Acquired with a NIDEK AFC-230.
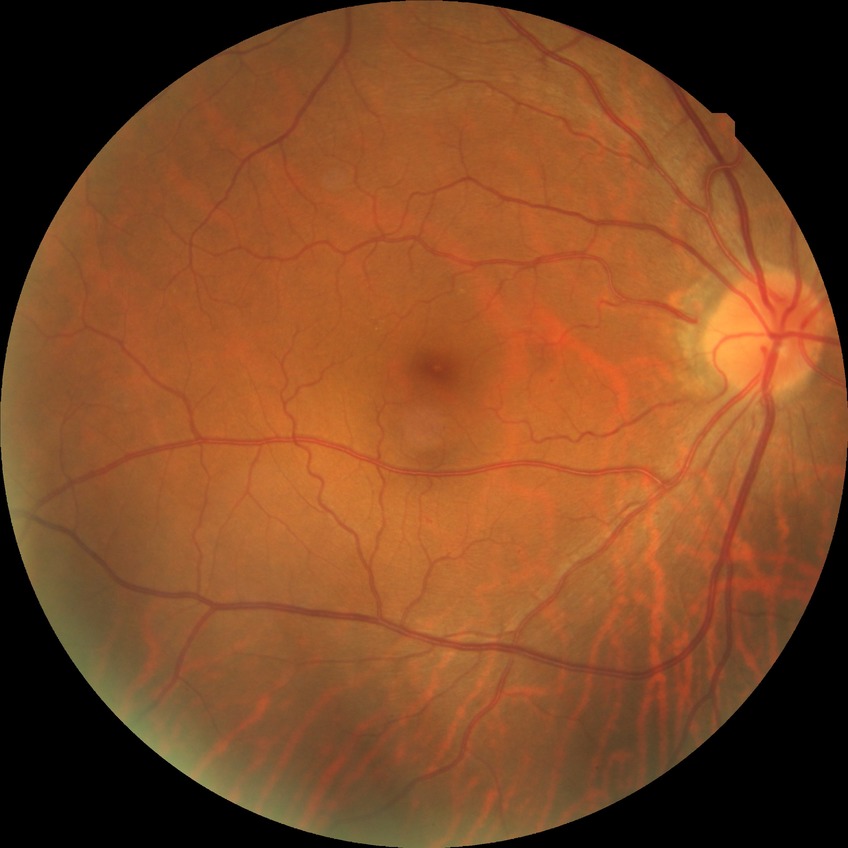
Diabetic retinopathy (DR): no diabetic retinopathy (NDR).